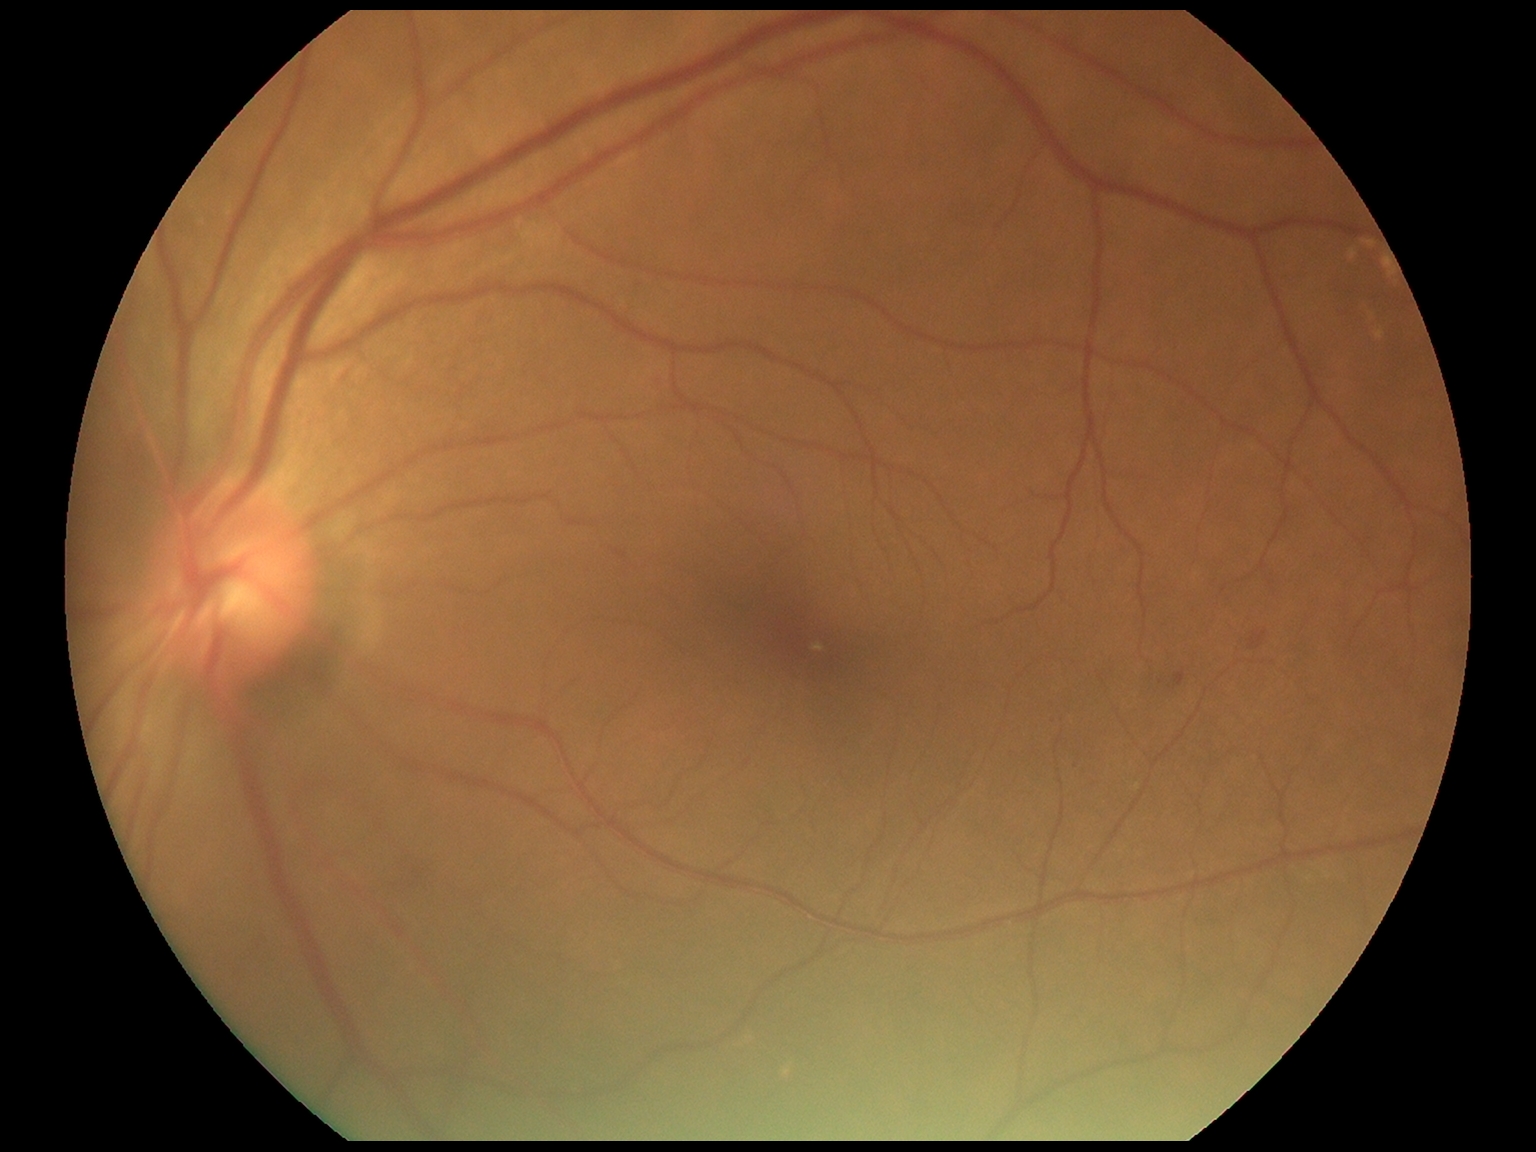 DR class: non-proliferative diabetic retinopathy, DR severity: moderate NPDR (grade 2).